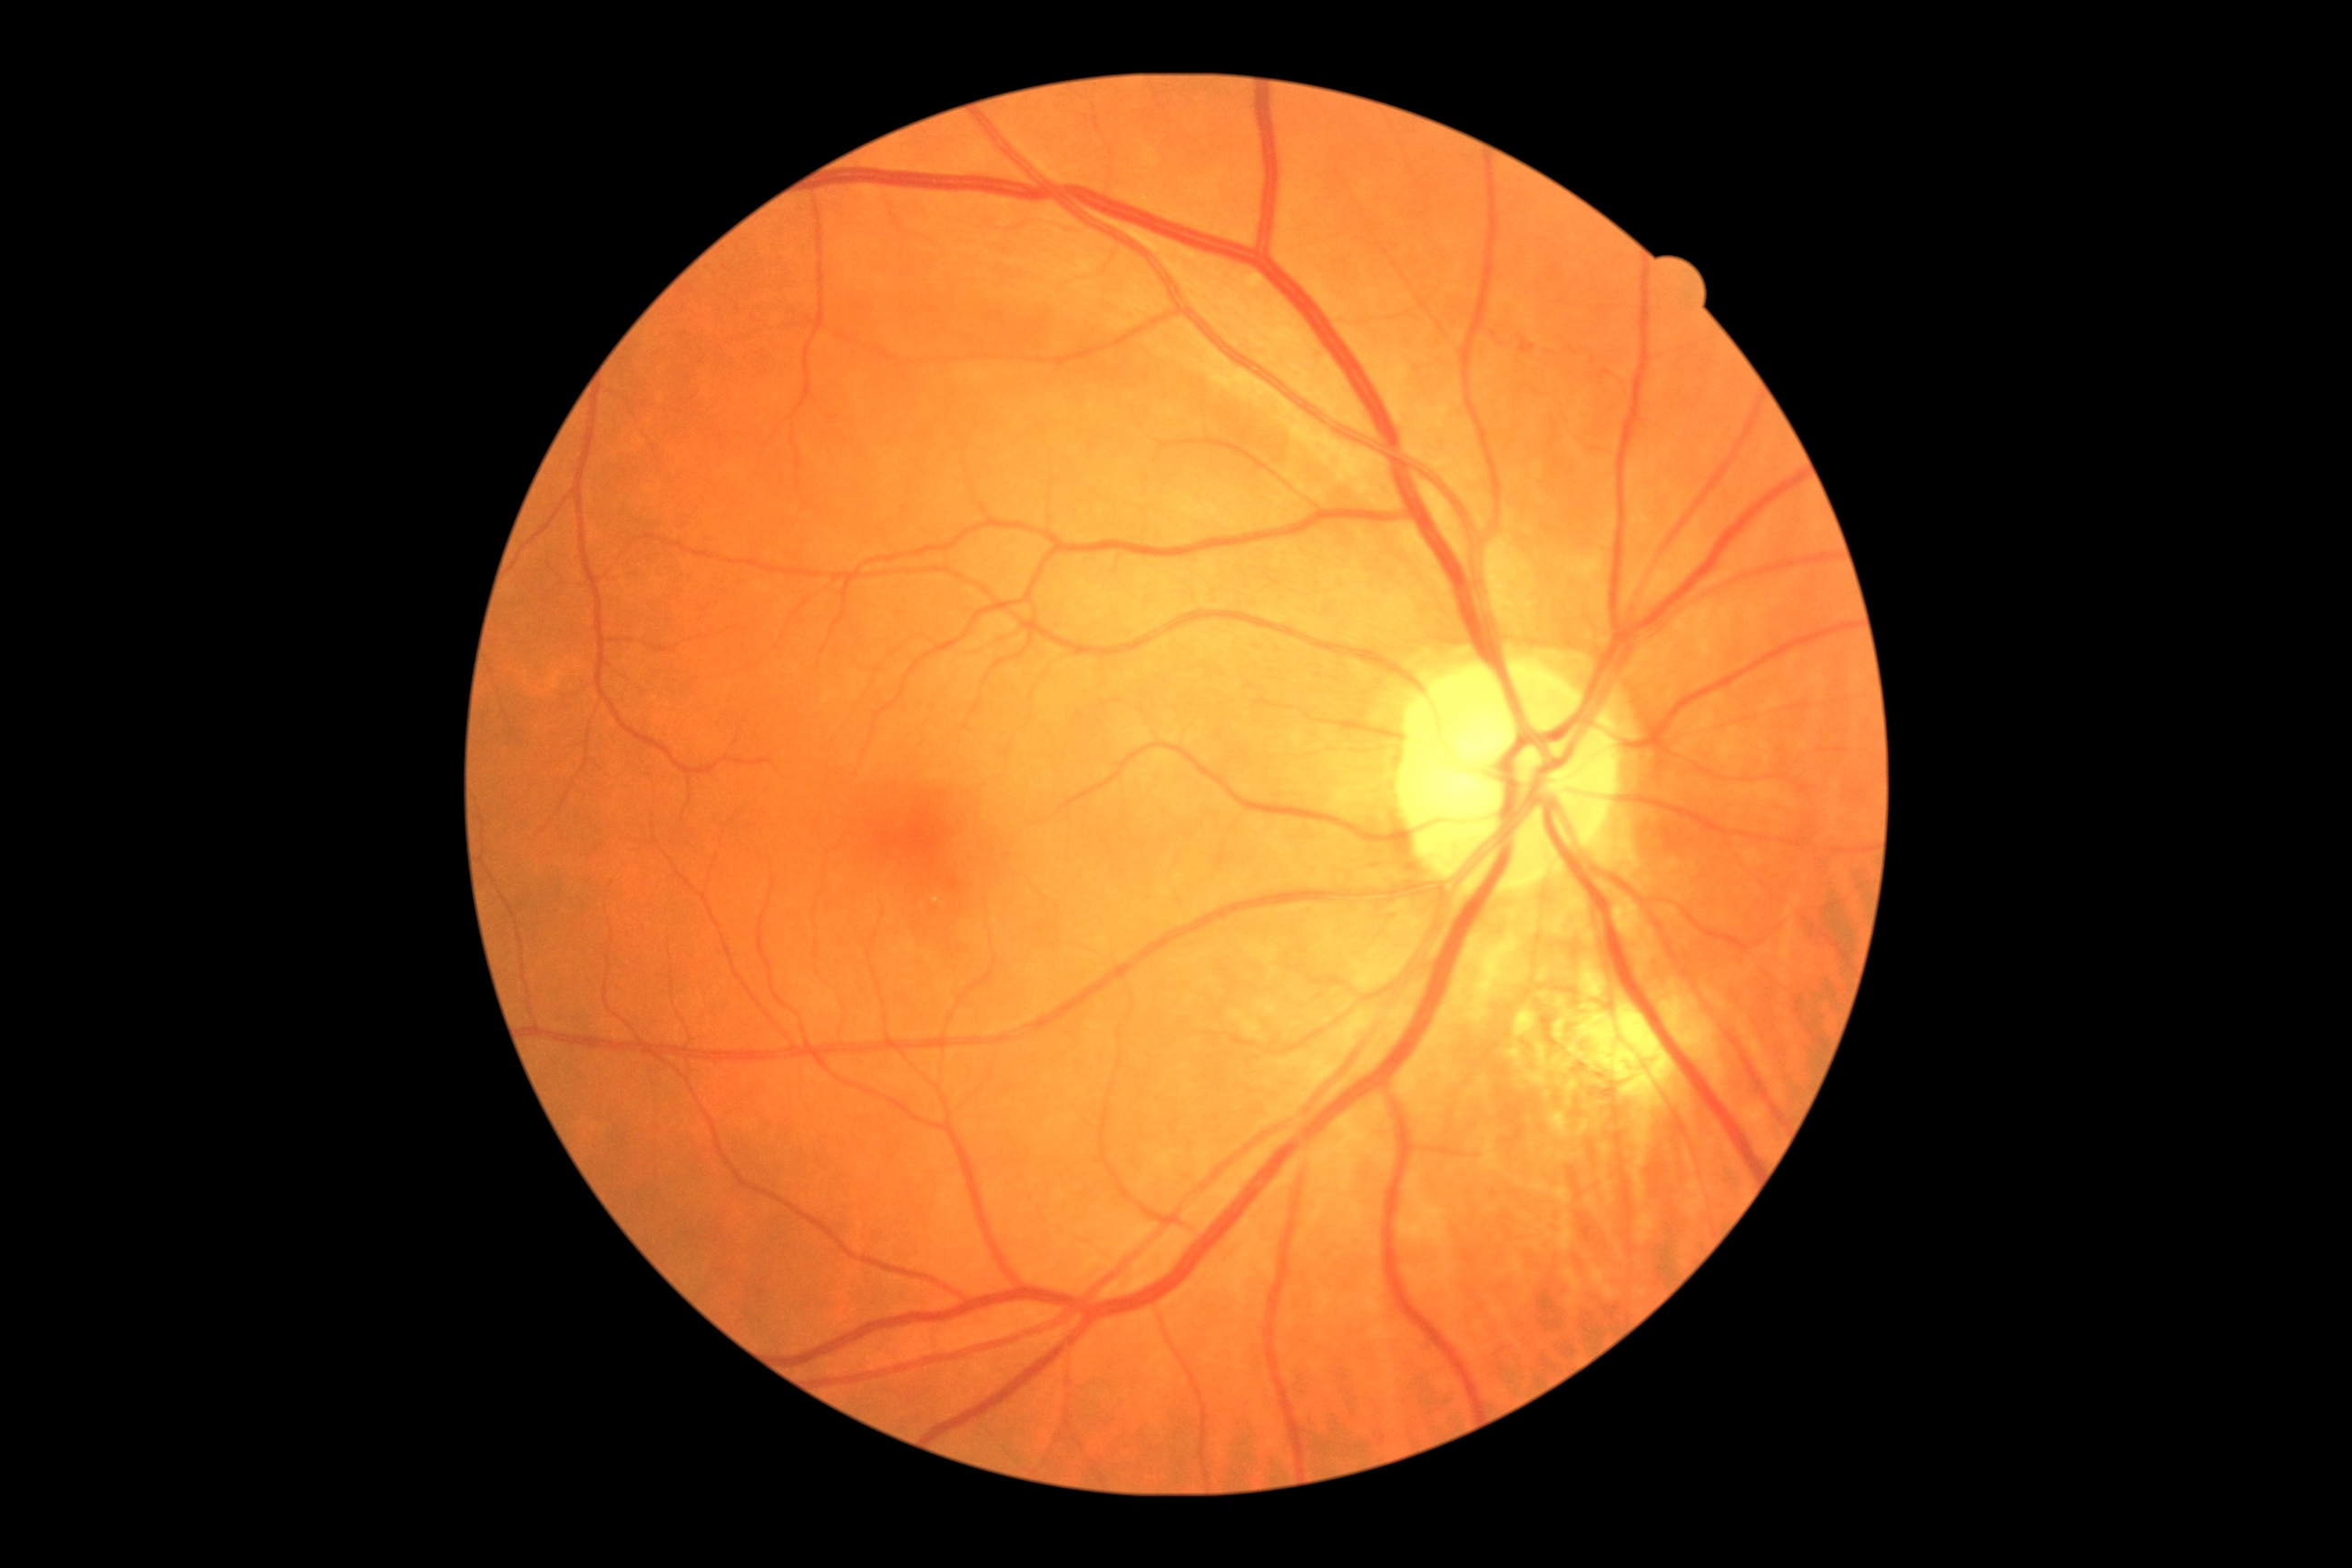 Diabetic retinopathy grade: moderate non-proliferative diabetic retinopathy (2) — more than just microaneurysms but less than severe NPDR.
The retinopathy is classified as non-proliferative diabetic retinopathy.